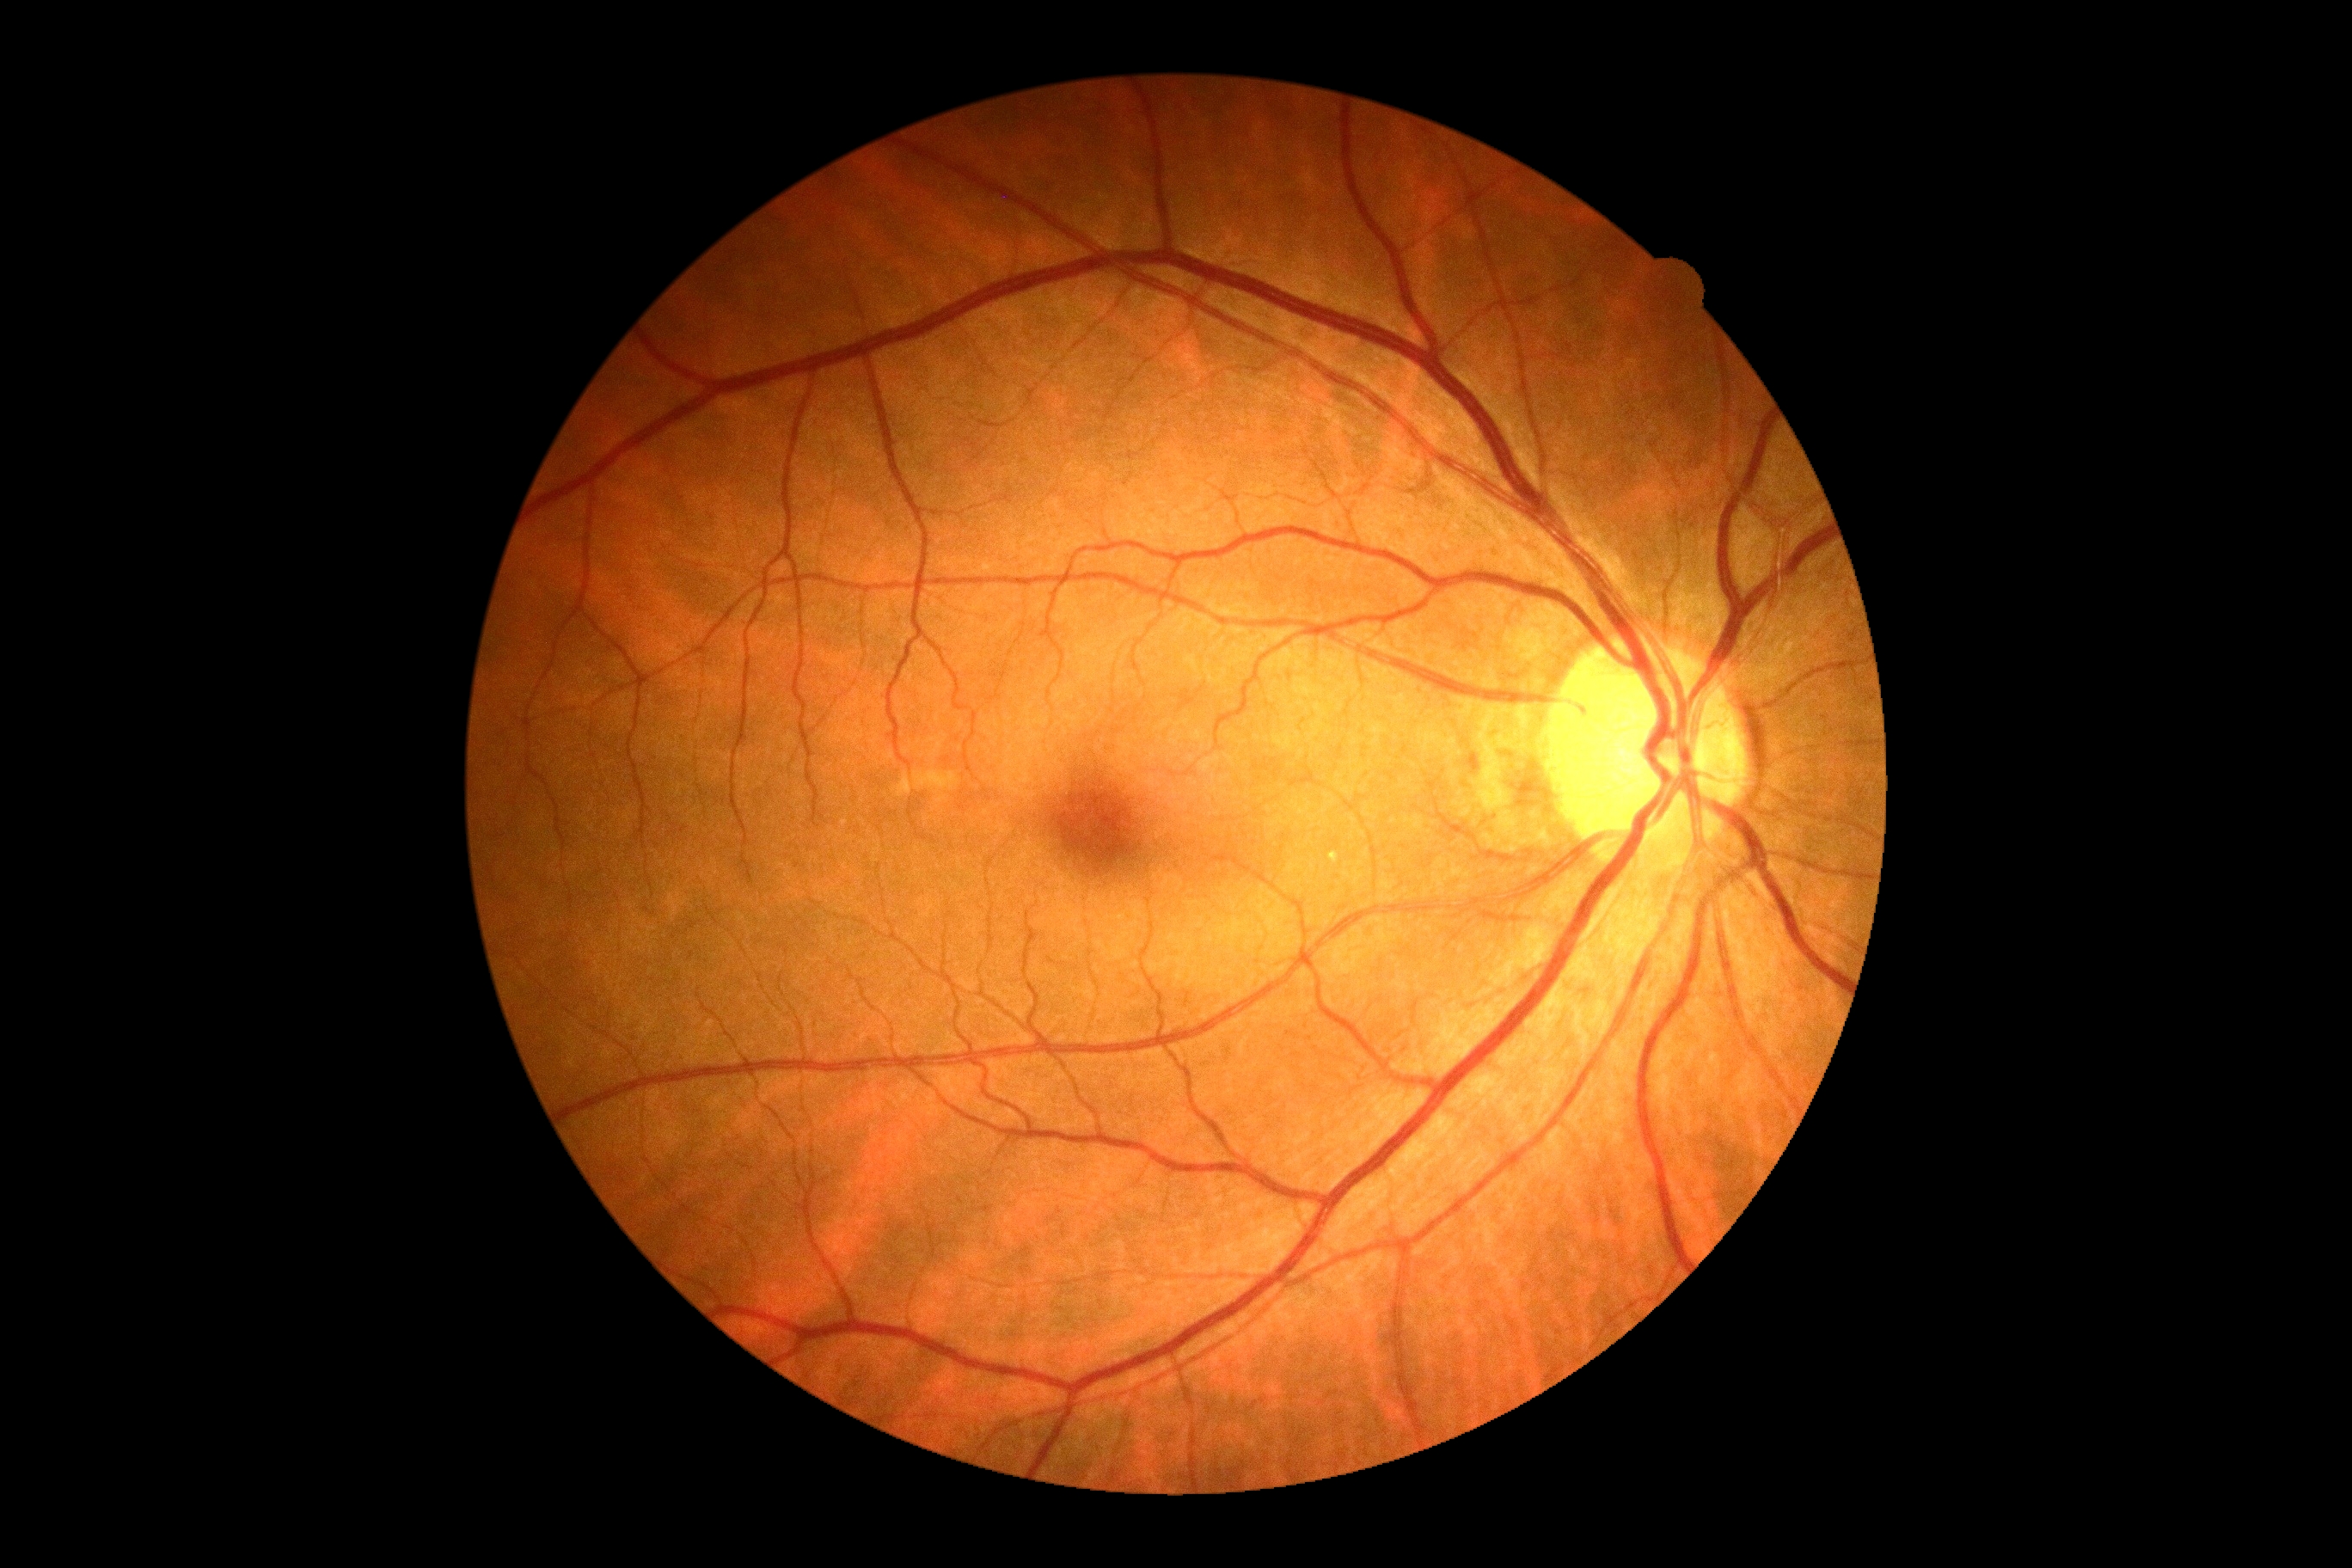
No DR findings.
Diabetic retinopathy (DR): 0.